Modified Davis grading.
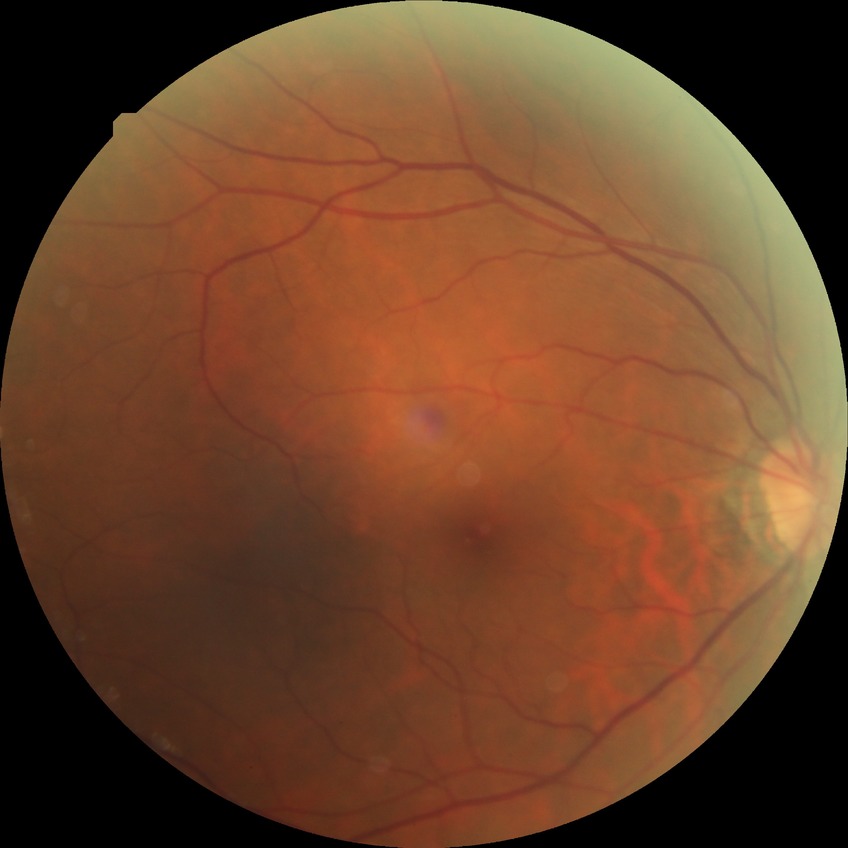 Diabetic retinopathy (DR) is NDR (no diabetic retinopathy).